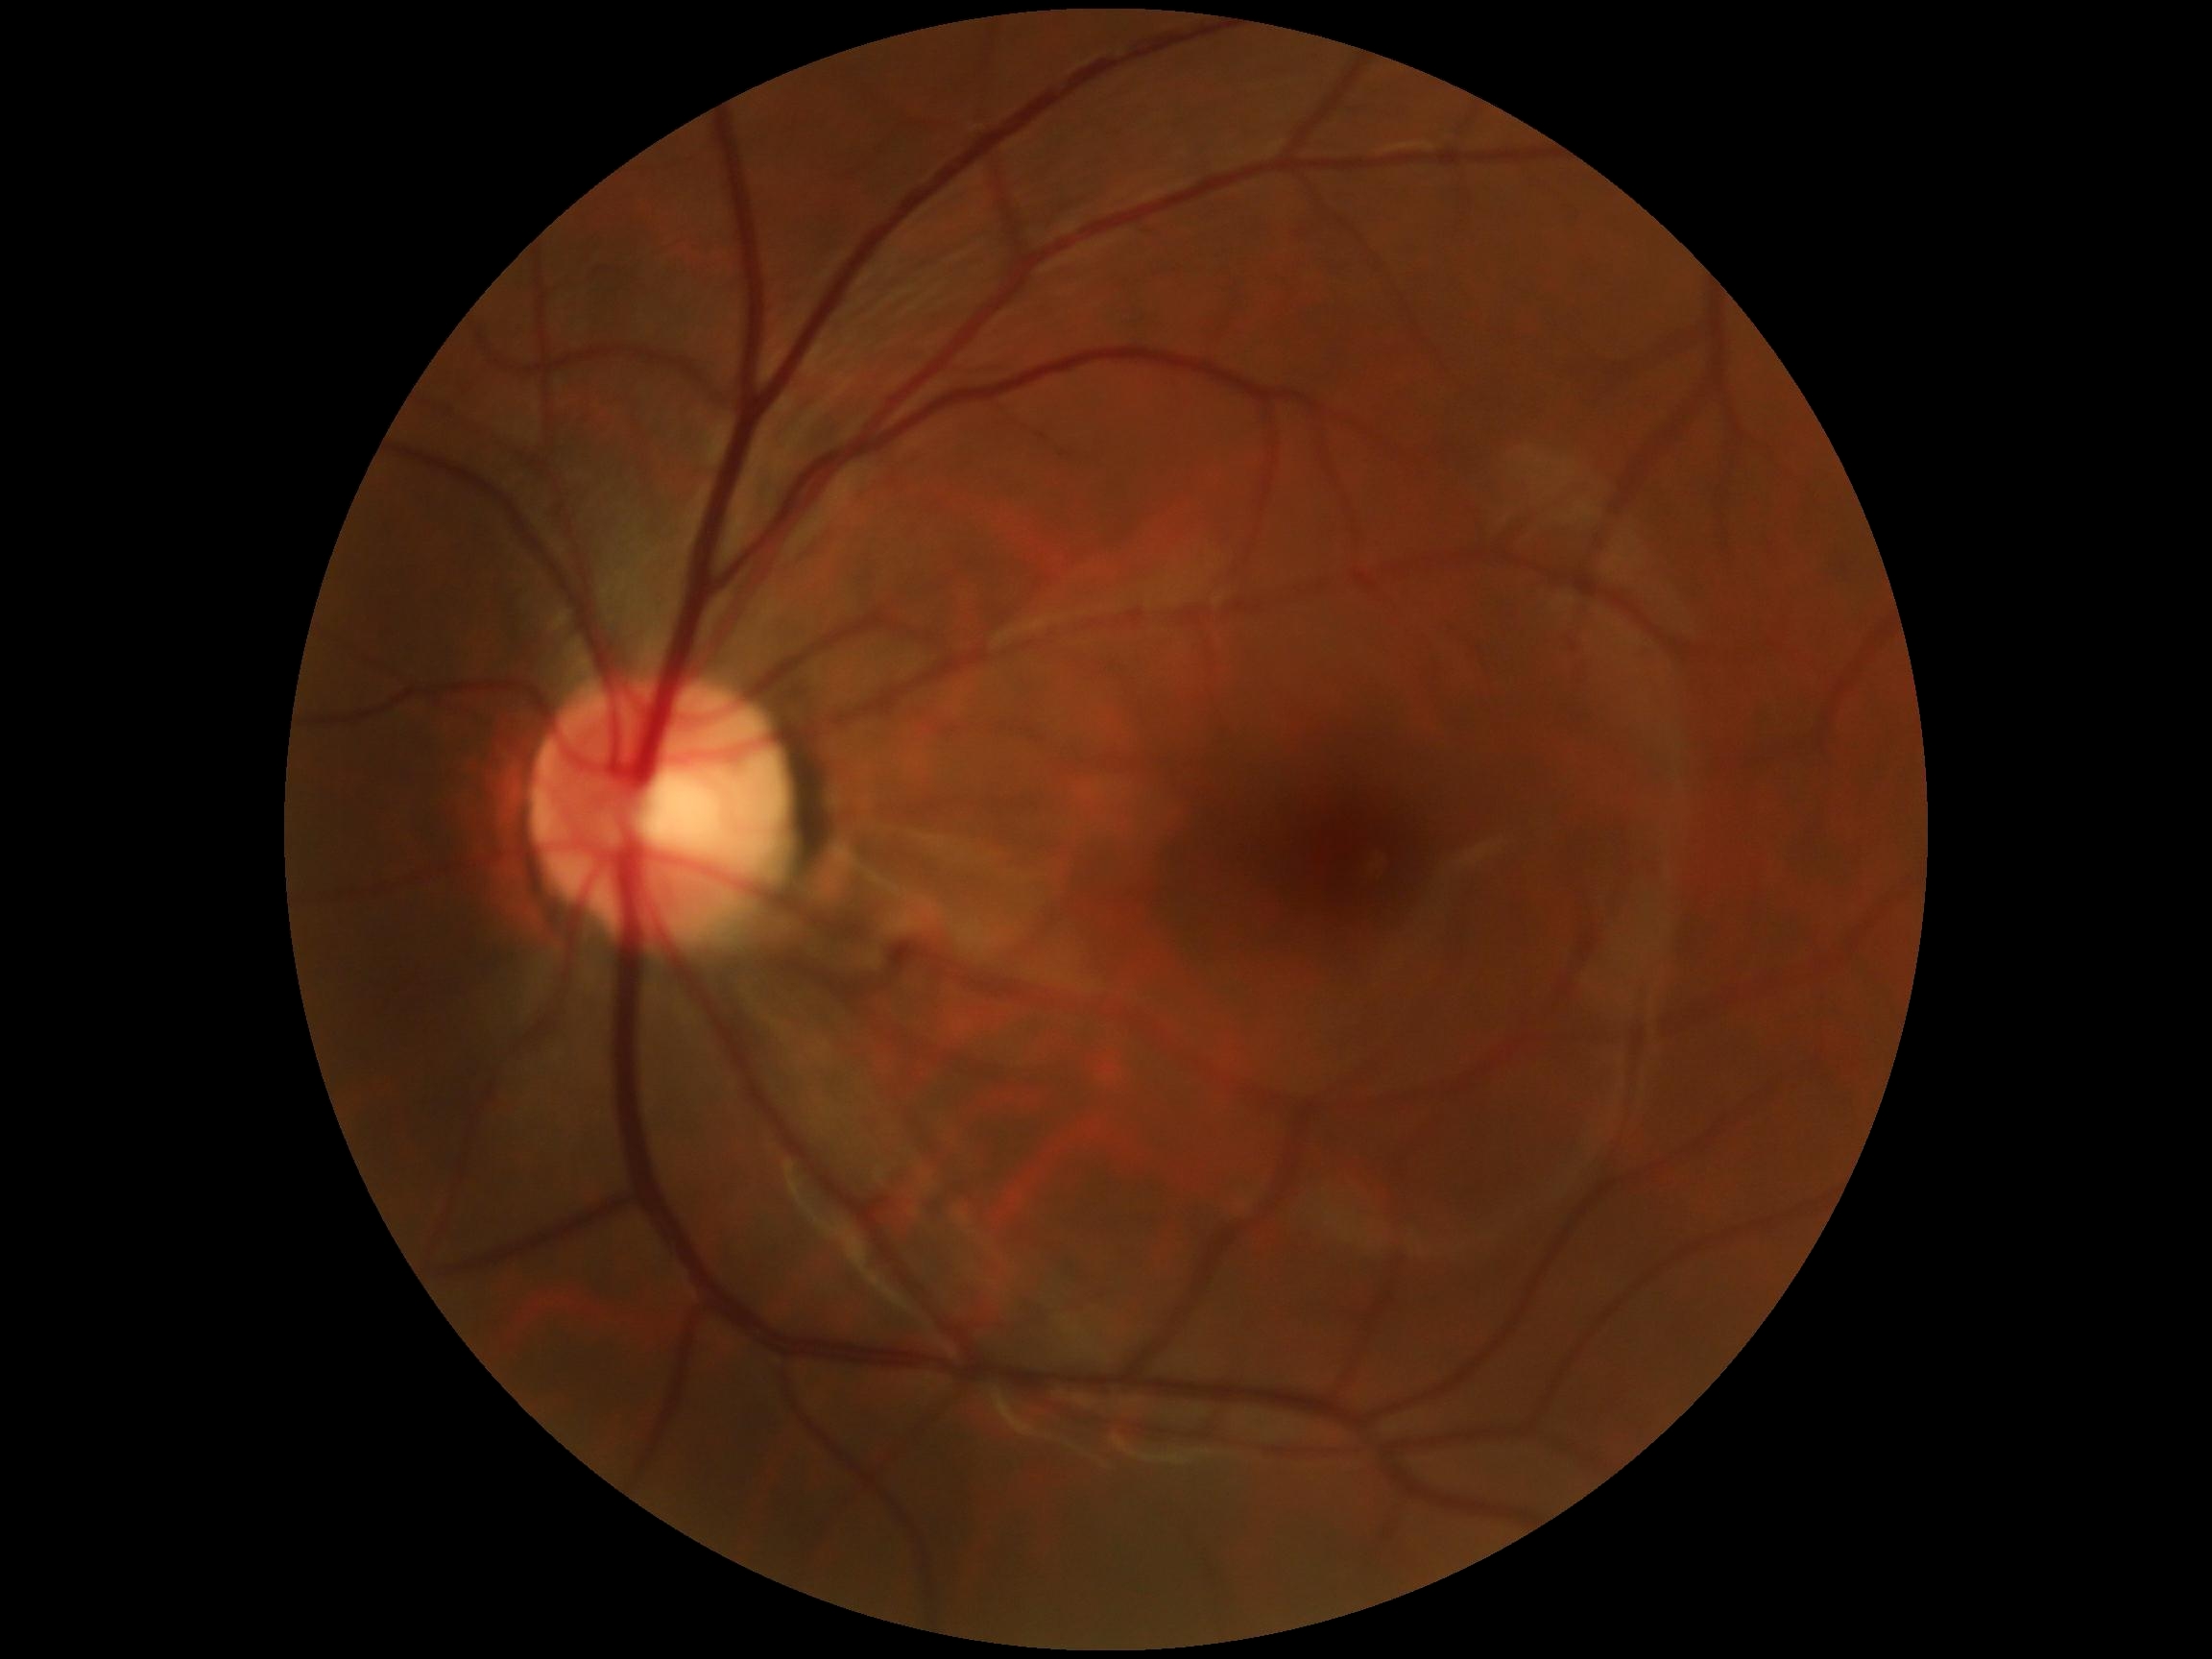
DR grade is no apparent retinopathy (0).